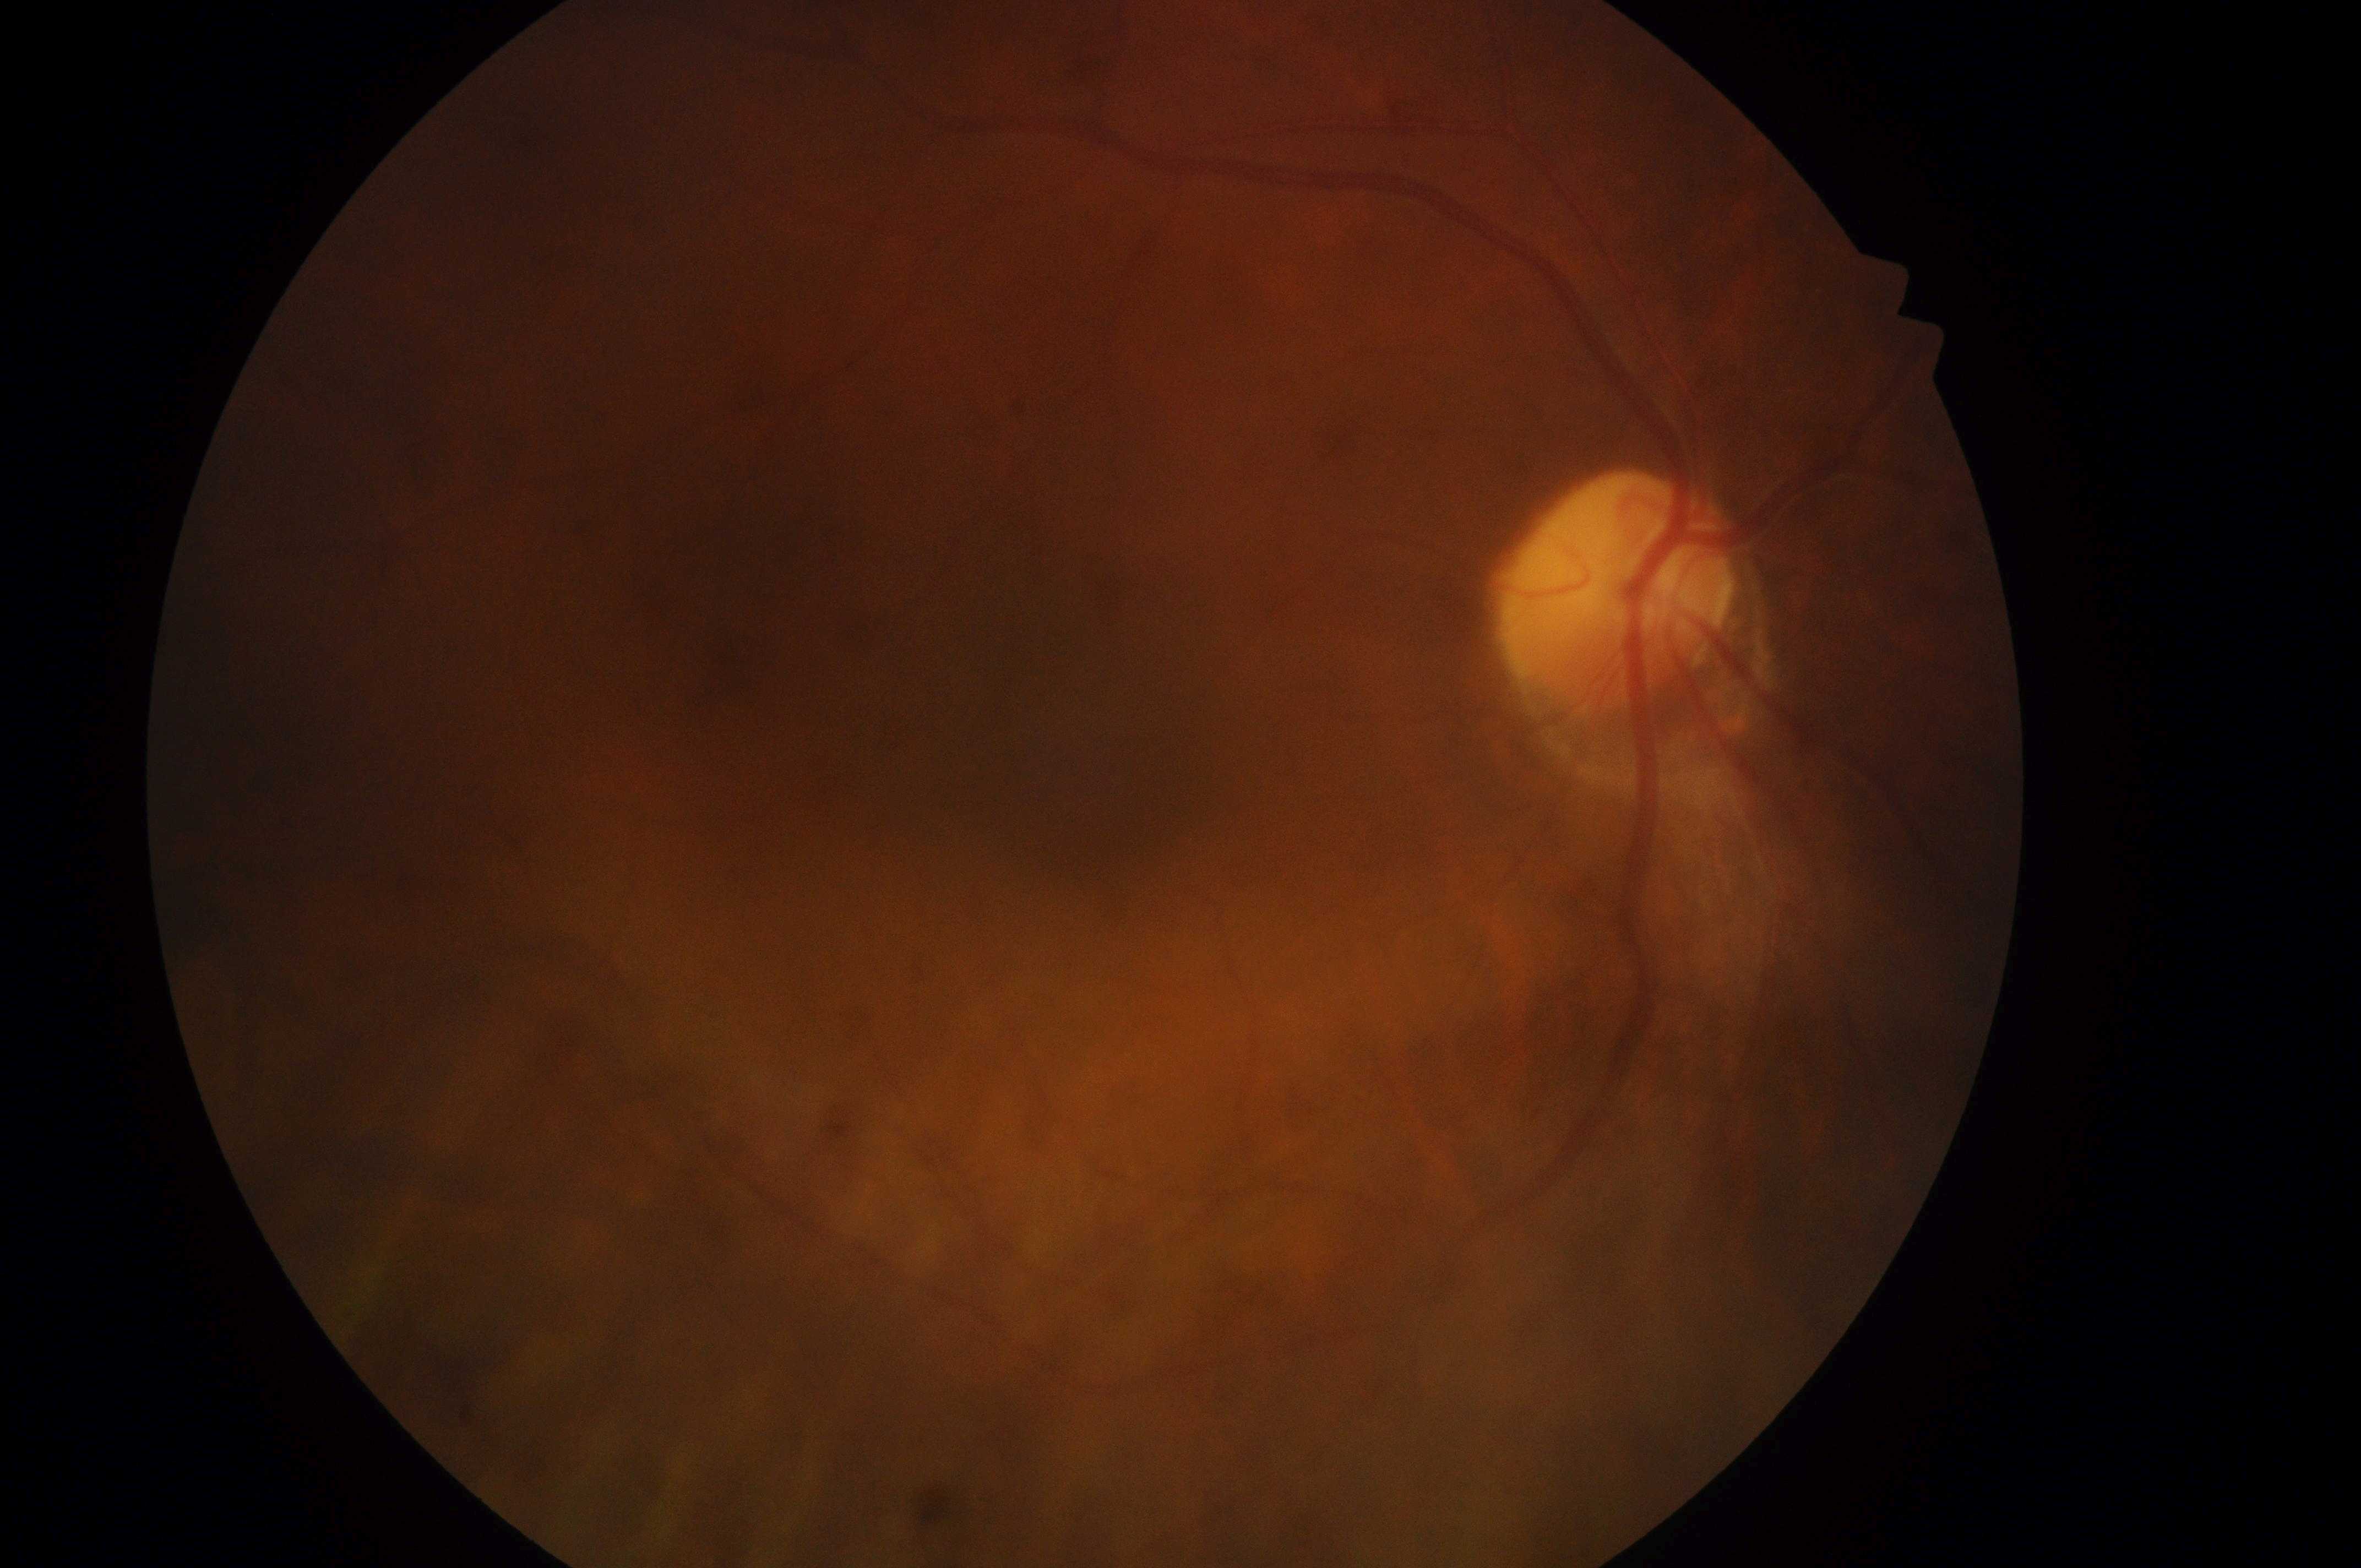

  fovea: 1073, 759
  eye: right eye
  dme_grade: 0/2
  optic_disc: 1613, 606
  dr_grade: 0/4
  dr_impression: No DR or DME findings